Image size 2352x1568.
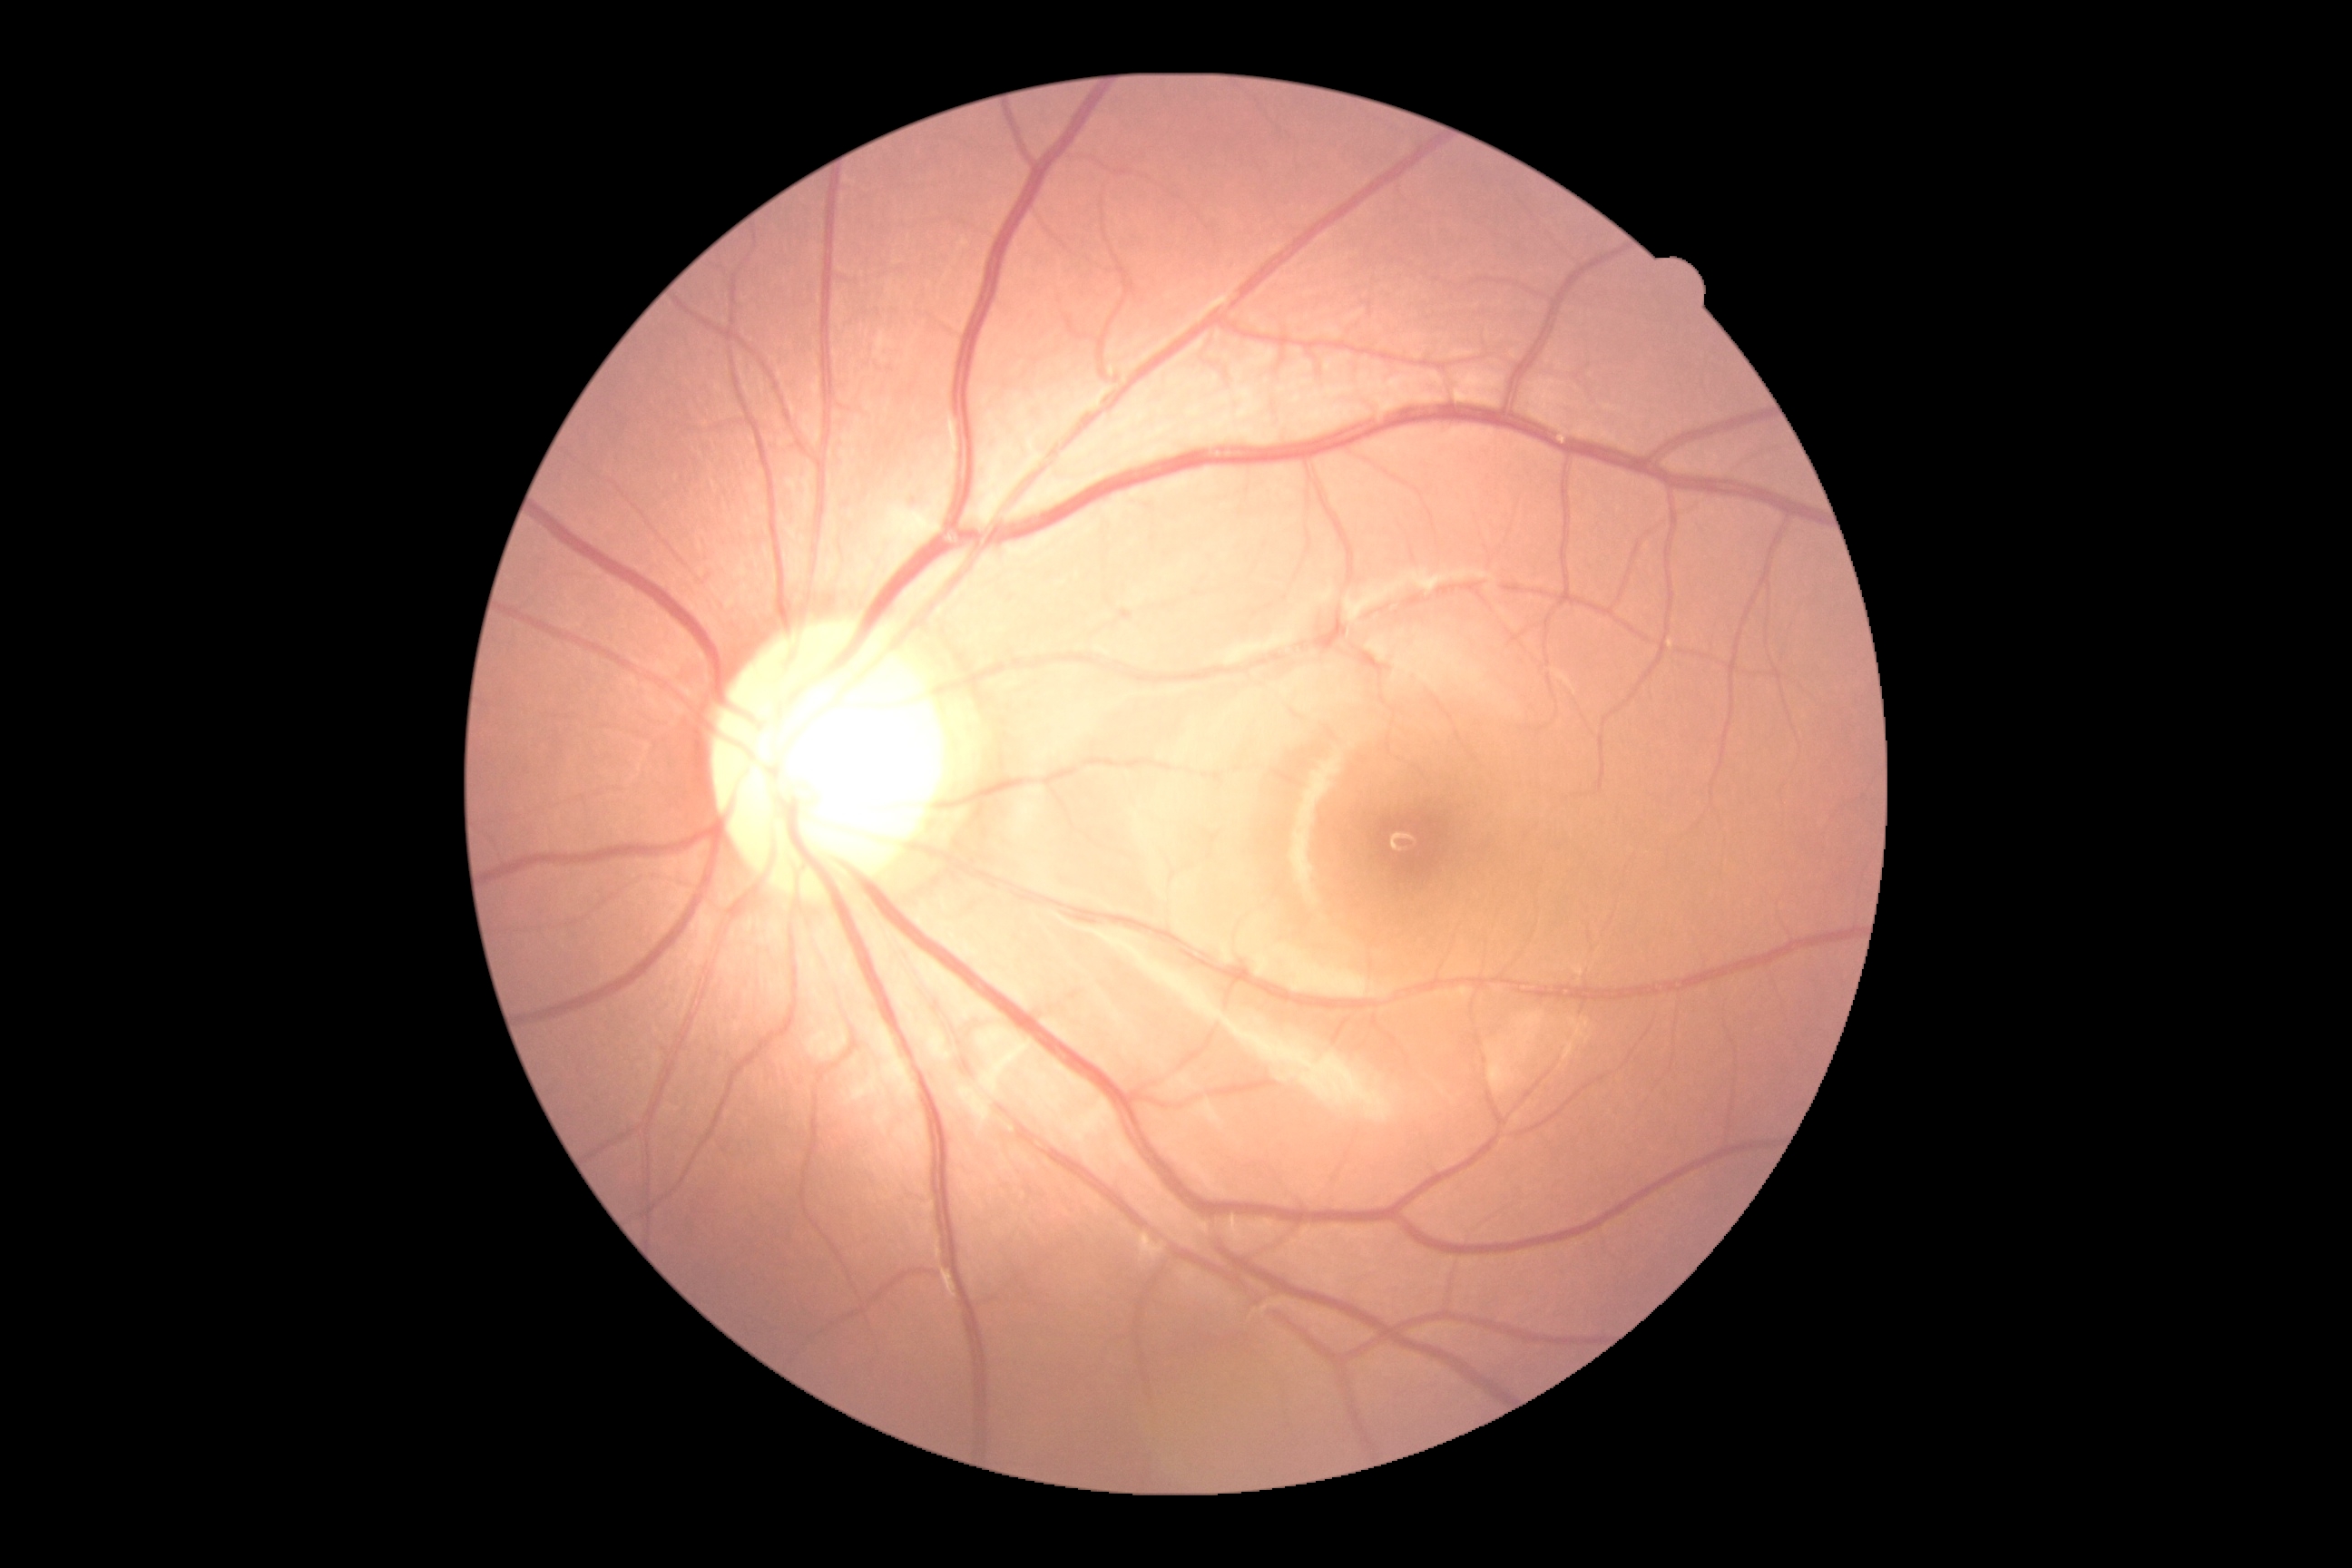

Retinopathy grade: 0 (no apparent retinopathy).